Retinal fundus photograph:
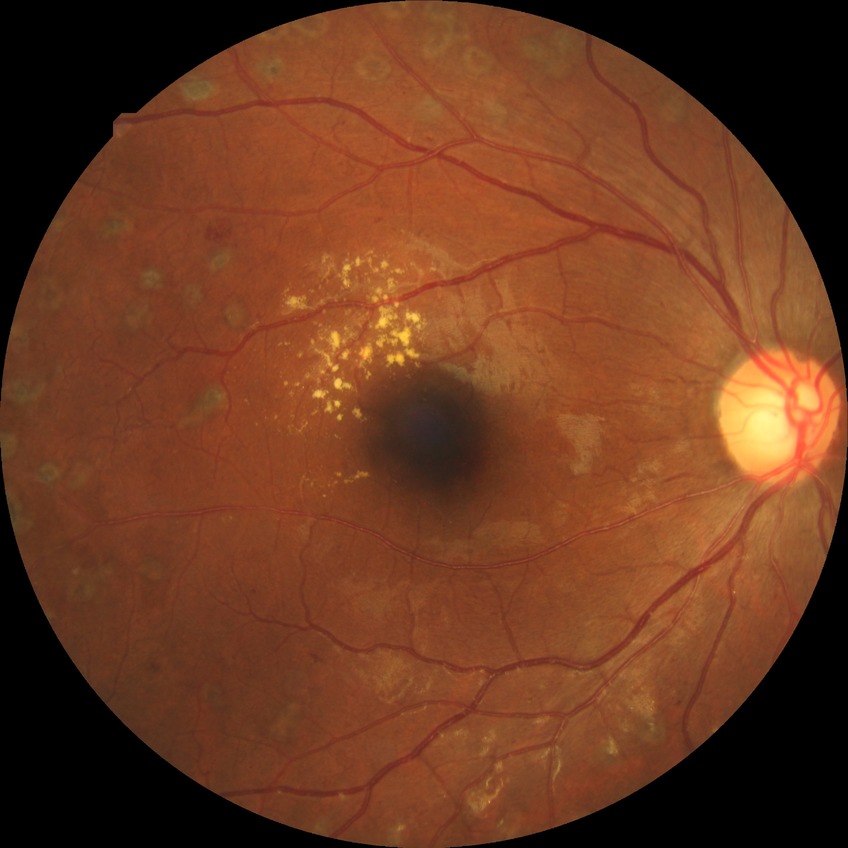

{"davis_grade": "PDR (proliferative diabetic retinopathy)"}